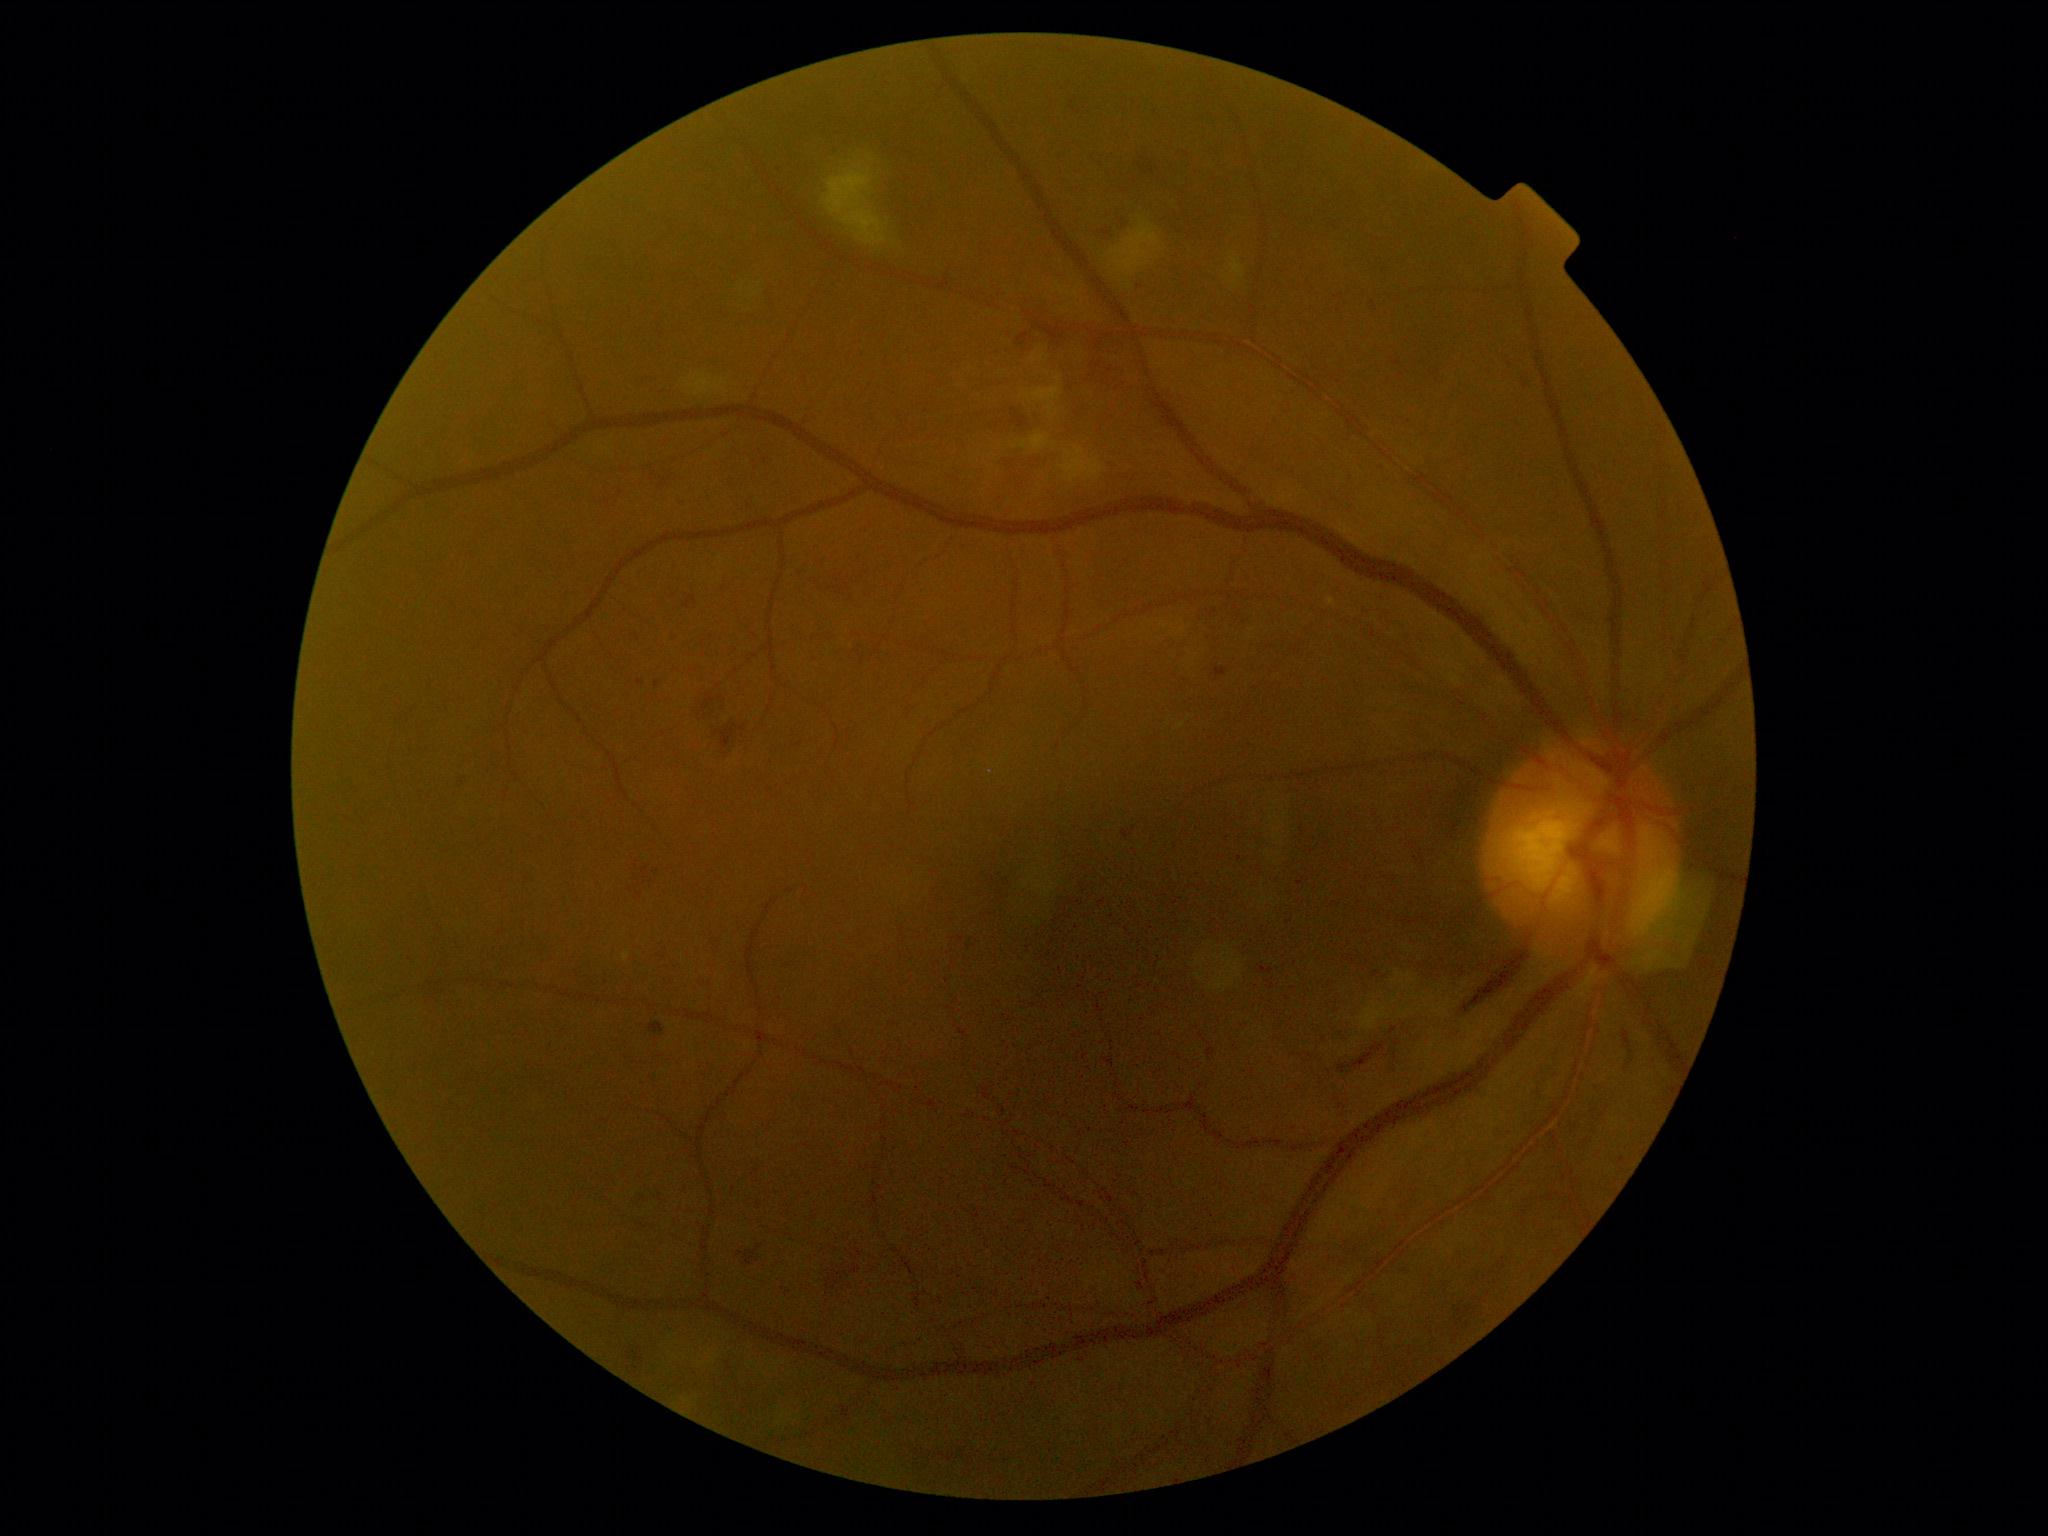

DR severity: grade 2 (moderate NPDR).